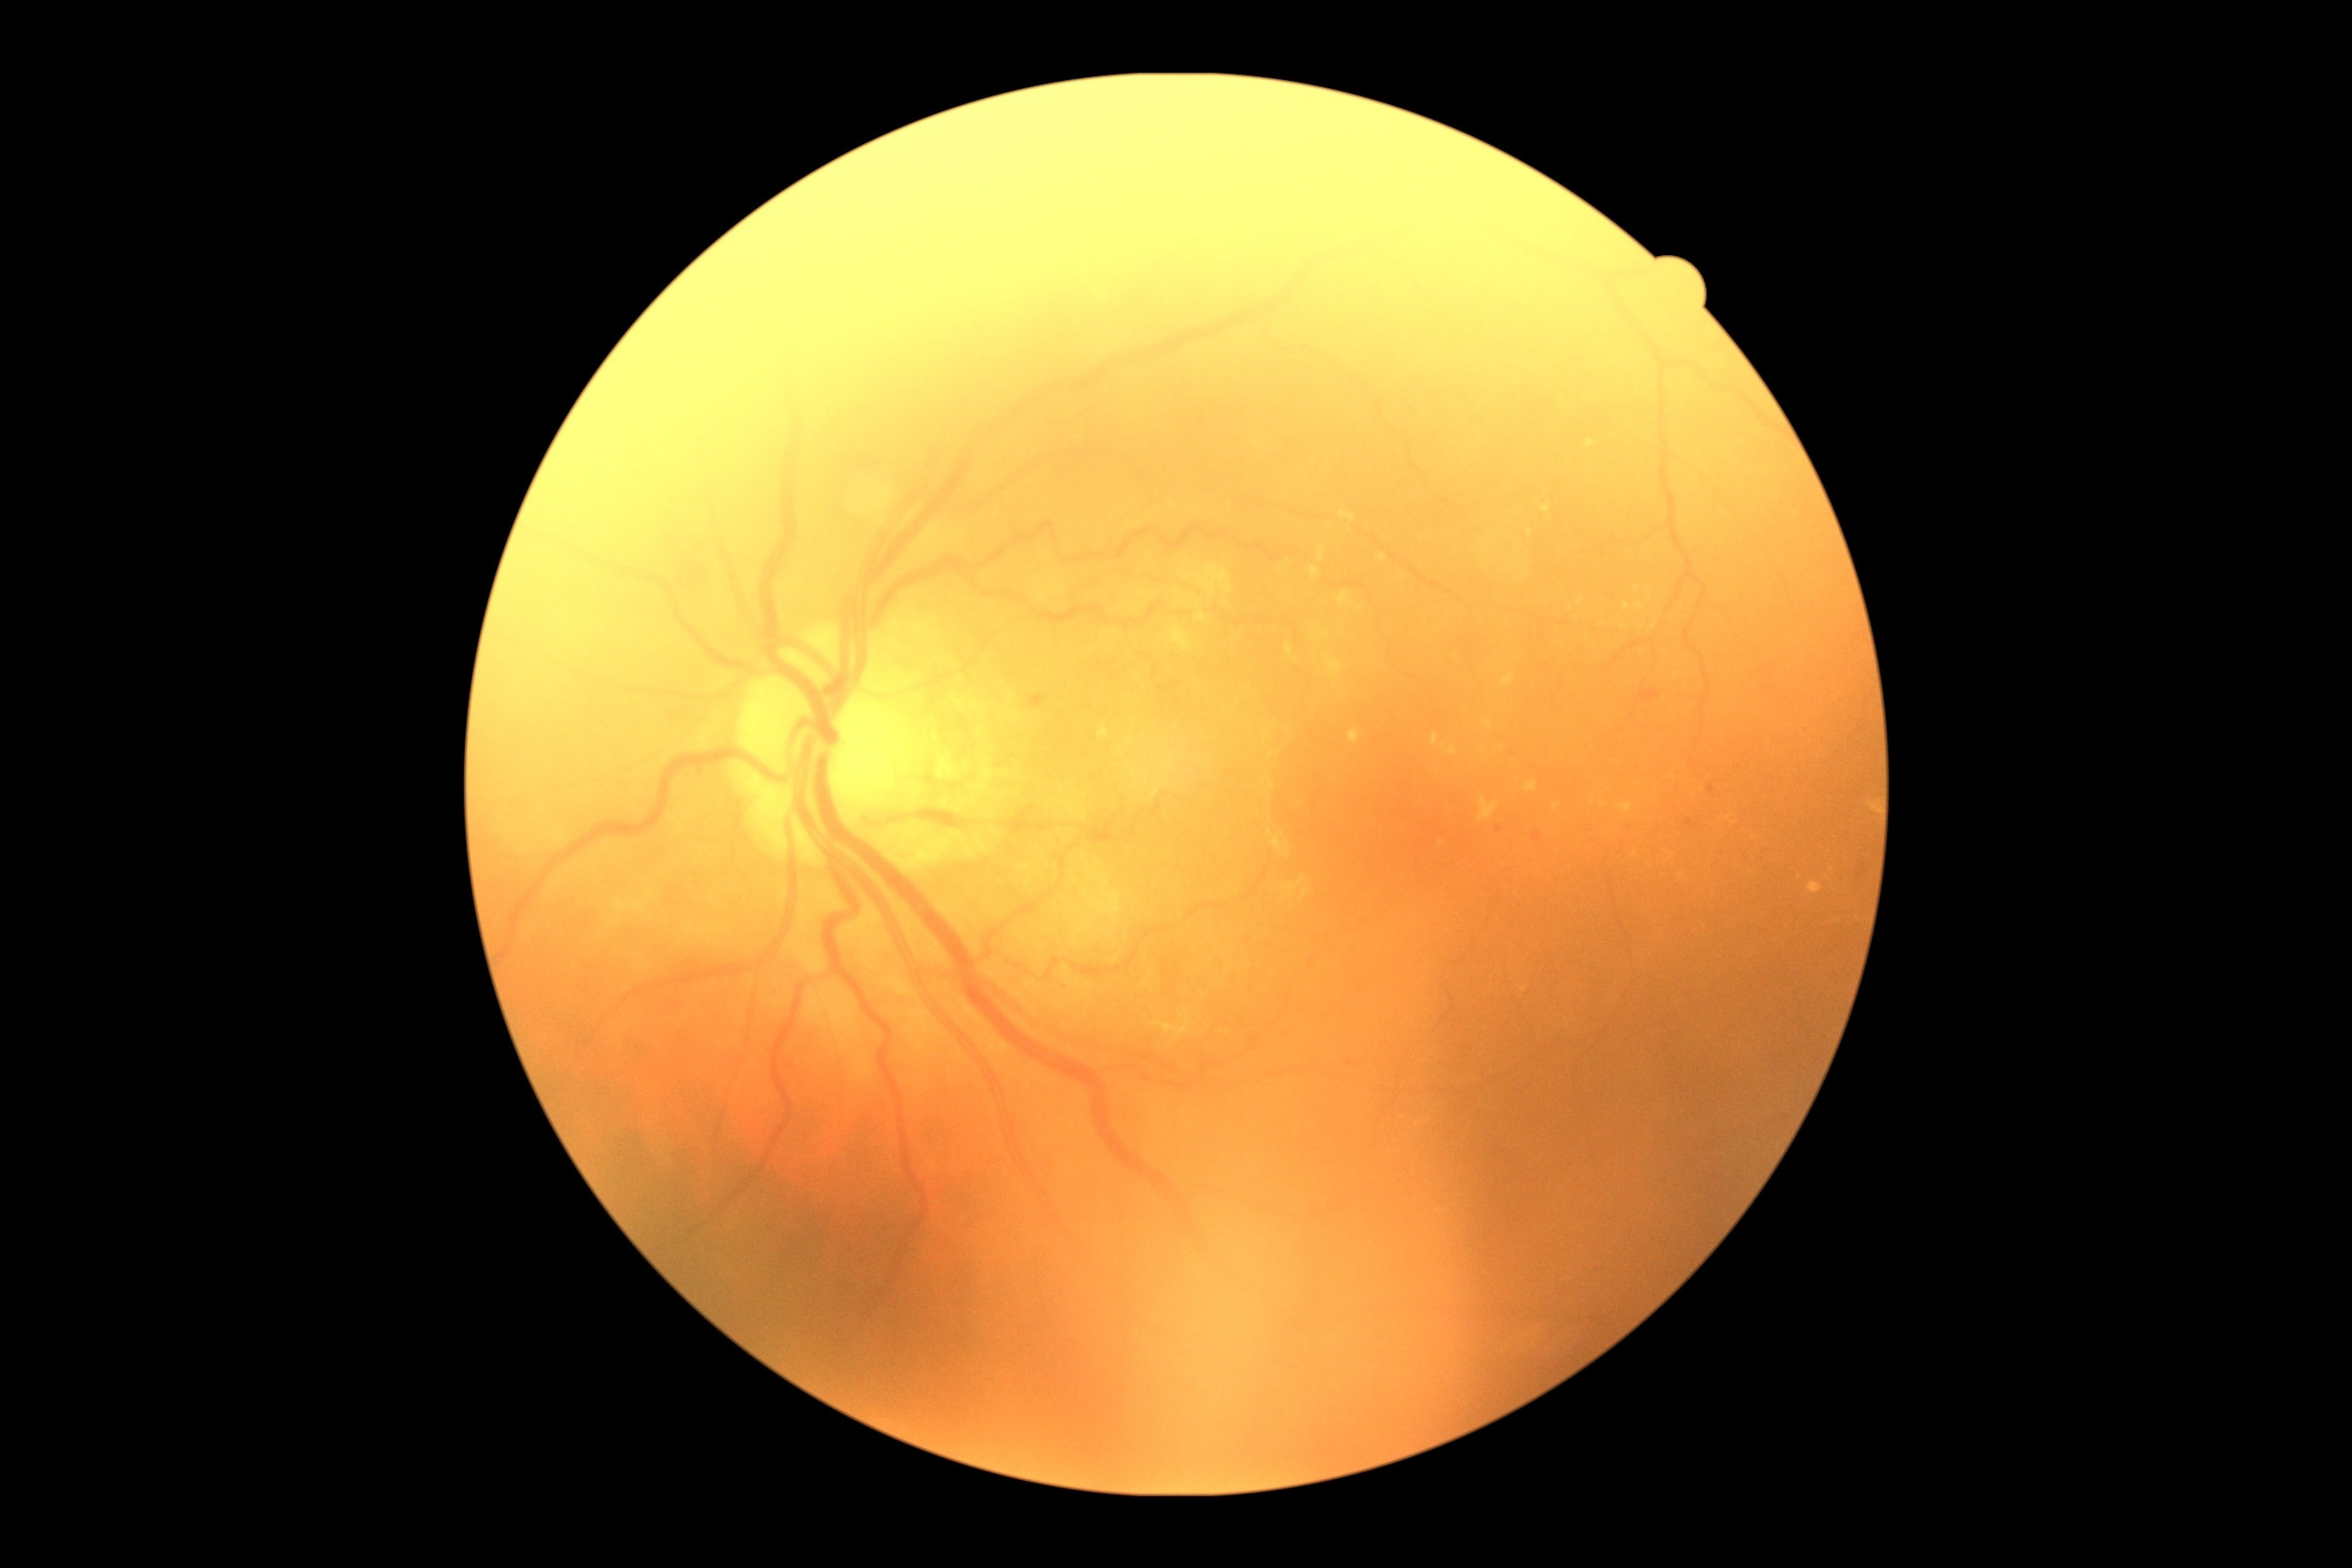 diabetic retinopathy grade@2/4.